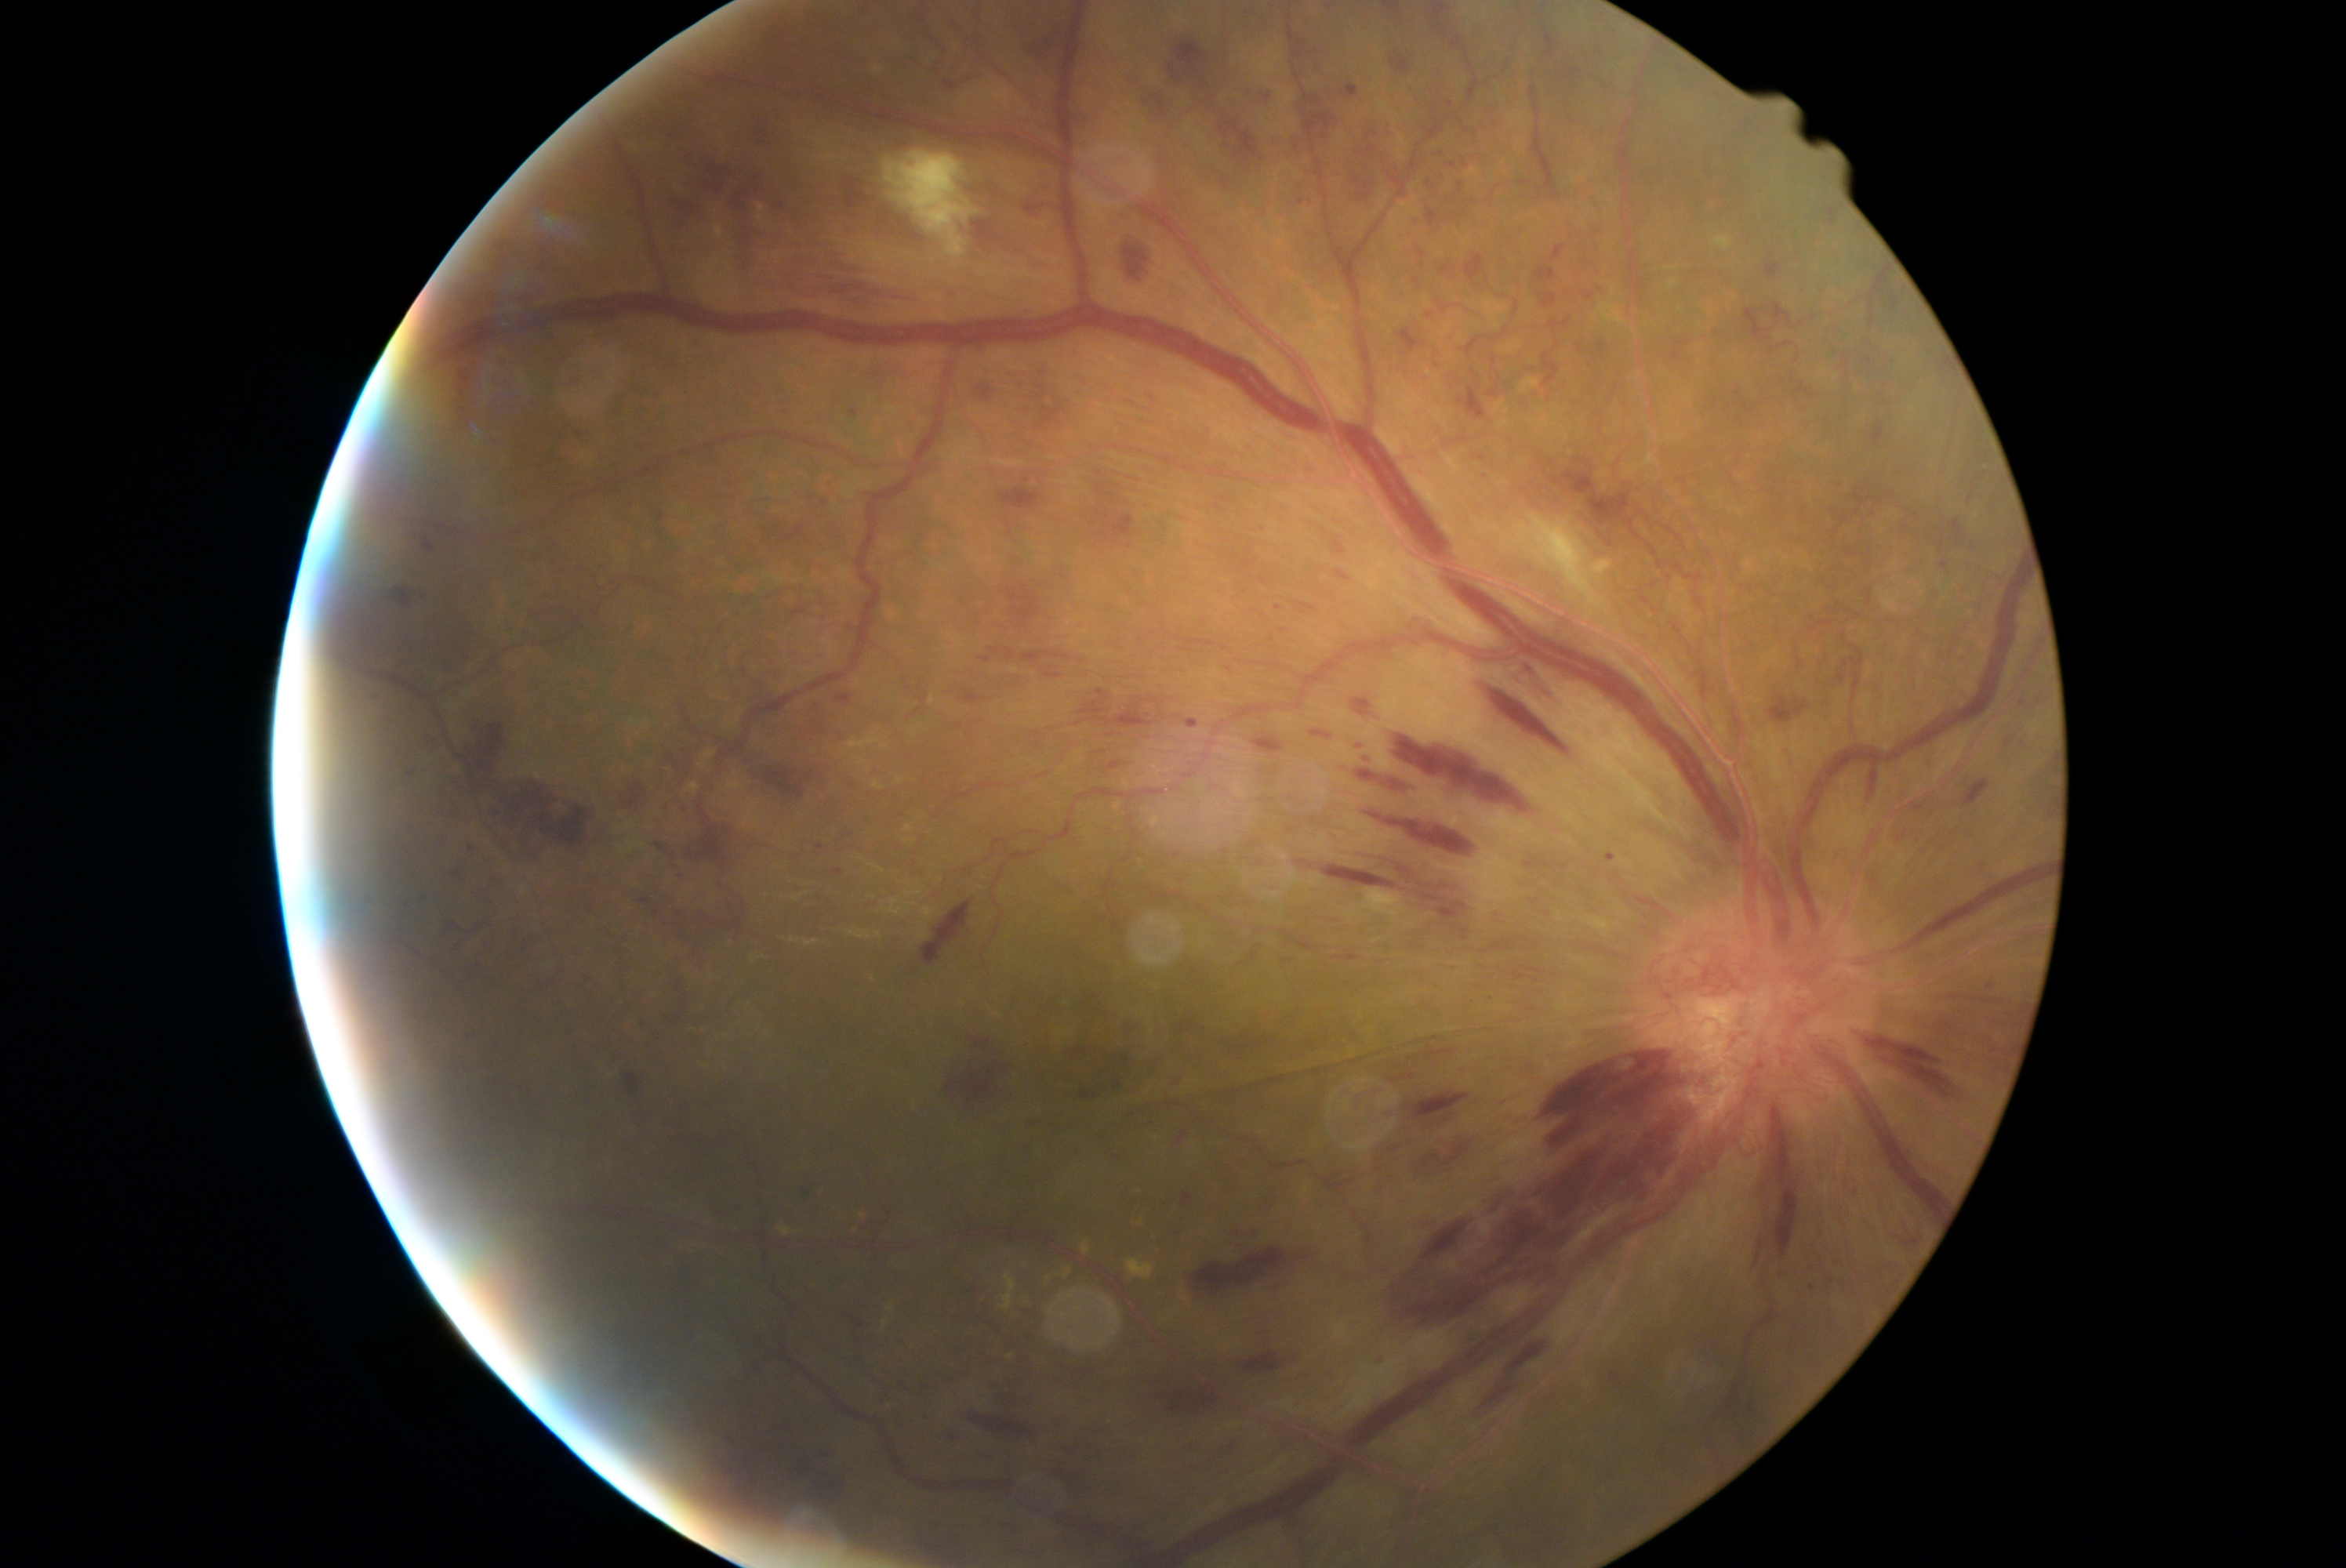 Diabetic retinopathy (DR) is grade 4; proliferative diabetic retinopathy
Selected lesions:
hemorrhages (HEs) (more not shown): <region>1348, 115, 1389, 206</region>; <region>1475, 683, 1574, 753</region>; <region>1182, 1191, 1194, 1207</region>; <region>835, 694, 852, 703</region>; <region>1837, 661, 1848, 684</region>; <region>730, 175, 783, 222</region>; <region>1502, 1341, 1547, 1384</region>; <region>1023, 195, 1044, 220</region>; <region>1892, 296, 1900, 310</region>; <region>1348, 699, 1379, 722</region>; <region>1418, 250, 1426, 256</region>; <region>1022, 24, 1059, 57</region>; <region>1304, 728, 1335, 739</region>; <region>1122, 245, 1149, 281</region>; <region>943, 1425, 967, 1442</region>; <region>652, 909, 661, 916</region>; <region>1273, 603, 1285, 614</region>; <region>2047, 813, 2055, 818</region>
Smaller HEs around x=1972, y=547; x=1532, y=483